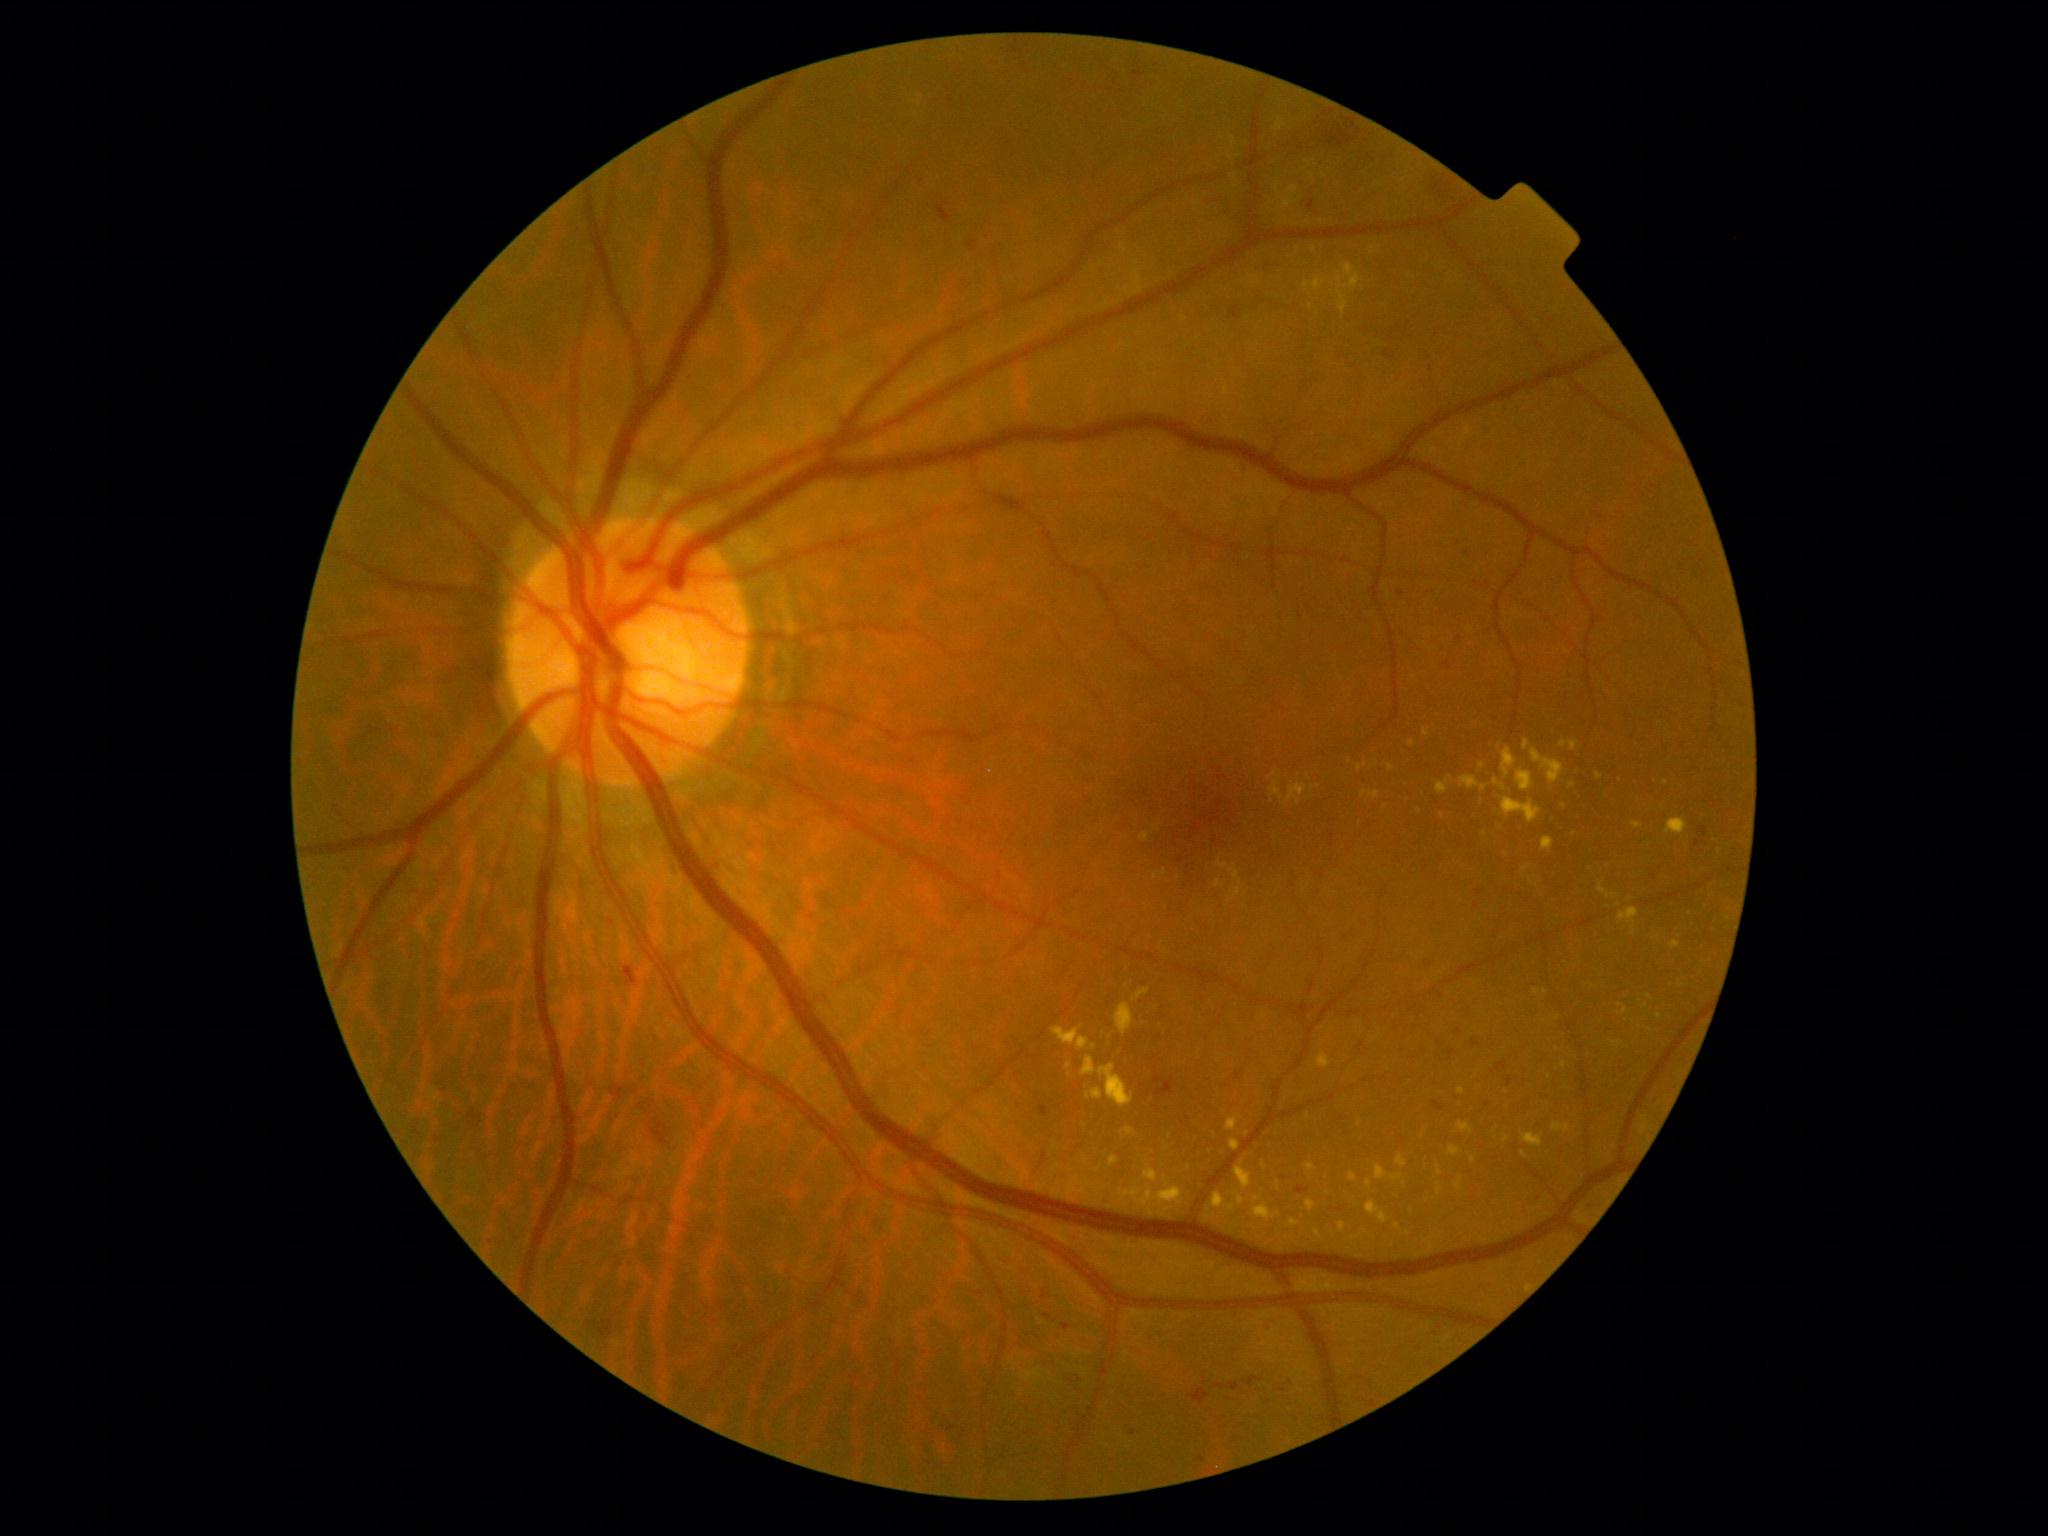
DR stage is grade 2 (moderate NPDR)
Selected lesions:
HEs: left=1325, top=126, right=1355, bottom=148, left=651, top=1119, right=670, bottom=1148, left=622, top=967, right=638, bottom=987, left=1433, top=181, right=1444, bottom=195, left=1229, top=307, right=1242, bottom=319, left=1245, top=1377, right=1264, bottom=1387, left=1156, top=1083, right=1173, bottom=1098, left=1256, top=260, right=1279, bottom=270, left=1189, top=1390, right=1211, bottom=1404, left=1384, top=350, right=1394, bottom=360
Additional small HEs near [x=1237, y=1350]
MAs (partial): left=1447, top=1050, right=1456, bottom=1061, left=948, top=1426, right=957, bottom=1432, left=1043, top=1293, right=1047, bottom=1301, left=1506, top=1077, right=1513, bottom=1089, left=1496, top=1062, right=1508, bottom=1073, left=1155, top=1076, right=1162, bottom=1085, left=1698, top=826, right=1708, bottom=838, left=1043, top=1314, right=1053, bottom=1320, left=1308, top=201, right=1315, bottom=211, left=1040, top=1106, right=1048, bottom=1118
Additional small MAs near [x=1133, y=1433], [x=1479, y=893], [x=1460, y=639], [x=1088, y=801], [x=1488, y=1105], [x=1291, y=1383], [x=1202, y=1460]
SEs: absent
EXs (partial): left=1269, top=773, right=1277, bottom=780, left=1391, top=1175, right=1401, bottom=1182, left=1304, top=278, right=1325, bottom=291, left=1671, top=941, right=1681, bottom=950, left=1552, top=1123, right=1571, bottom=1133, left=1338, top=1222, right=1347, bottom=1234, left=1054, top=1027, right=1090, bottom=1052, left=1099, top=1064, right=1133, bottom=1109, left=1618, top=908, right=1639, bottom=924, left=1218, top=859, right=1228, bottom=871, left=1229, top=1140, right=1241, bottom=1152, left=1541, top=838, right=1555, bottom=853, left=1365, top=1201, right=1388, bottom=1224
Additional small EXs near [x=1462, y=1092], [x=1349, y=762], [x=1461, y=1105], [x=1574, y=835], [x=1563, y=744], [x=1094, y=1047]